130° field of view (Clarity RetCam 3) · pediatric retinal photograph (wide-field) — 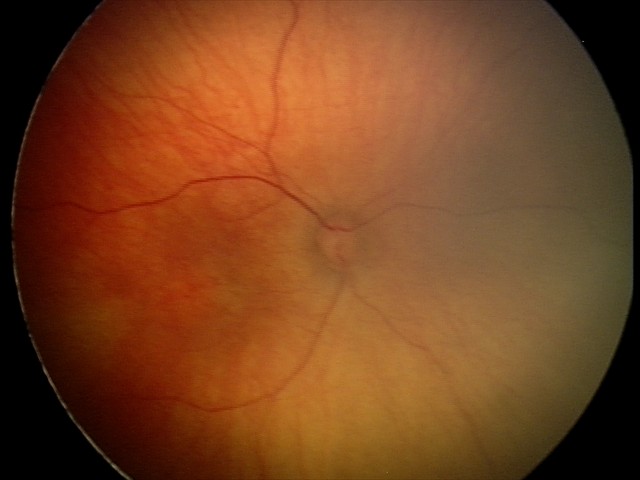
Screening examination with no abnormal retinal findings.